Davis DR grading — 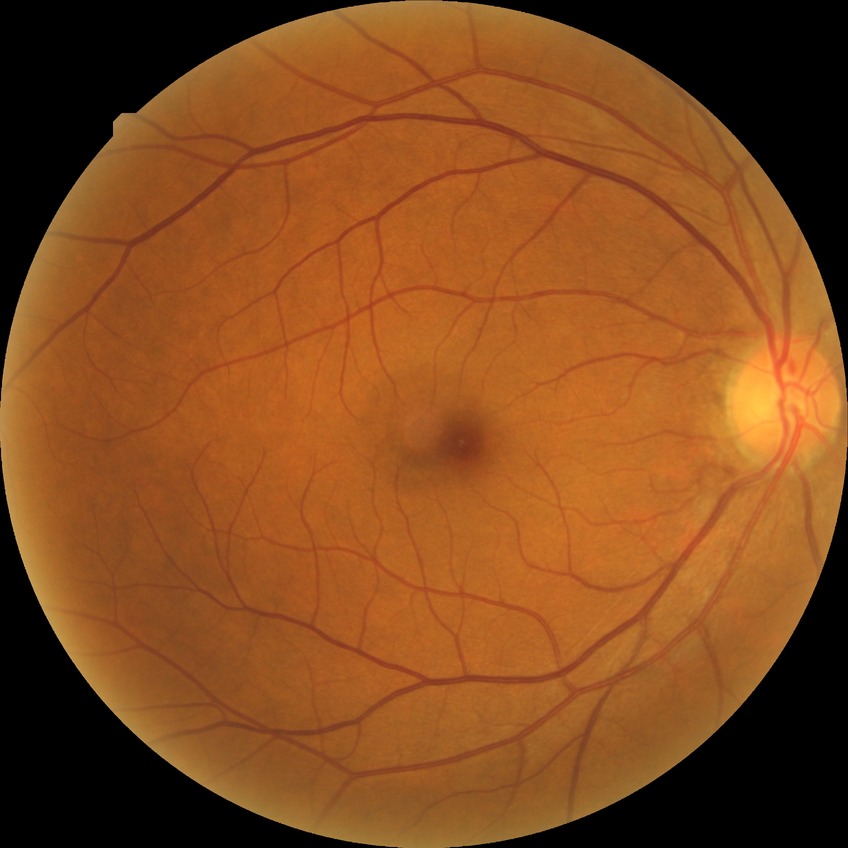

• diabetic retinopathy (DR): no diabetic retinopathy (NDR)